Ultra-widefield fundus mosaic · image size 1924x1556
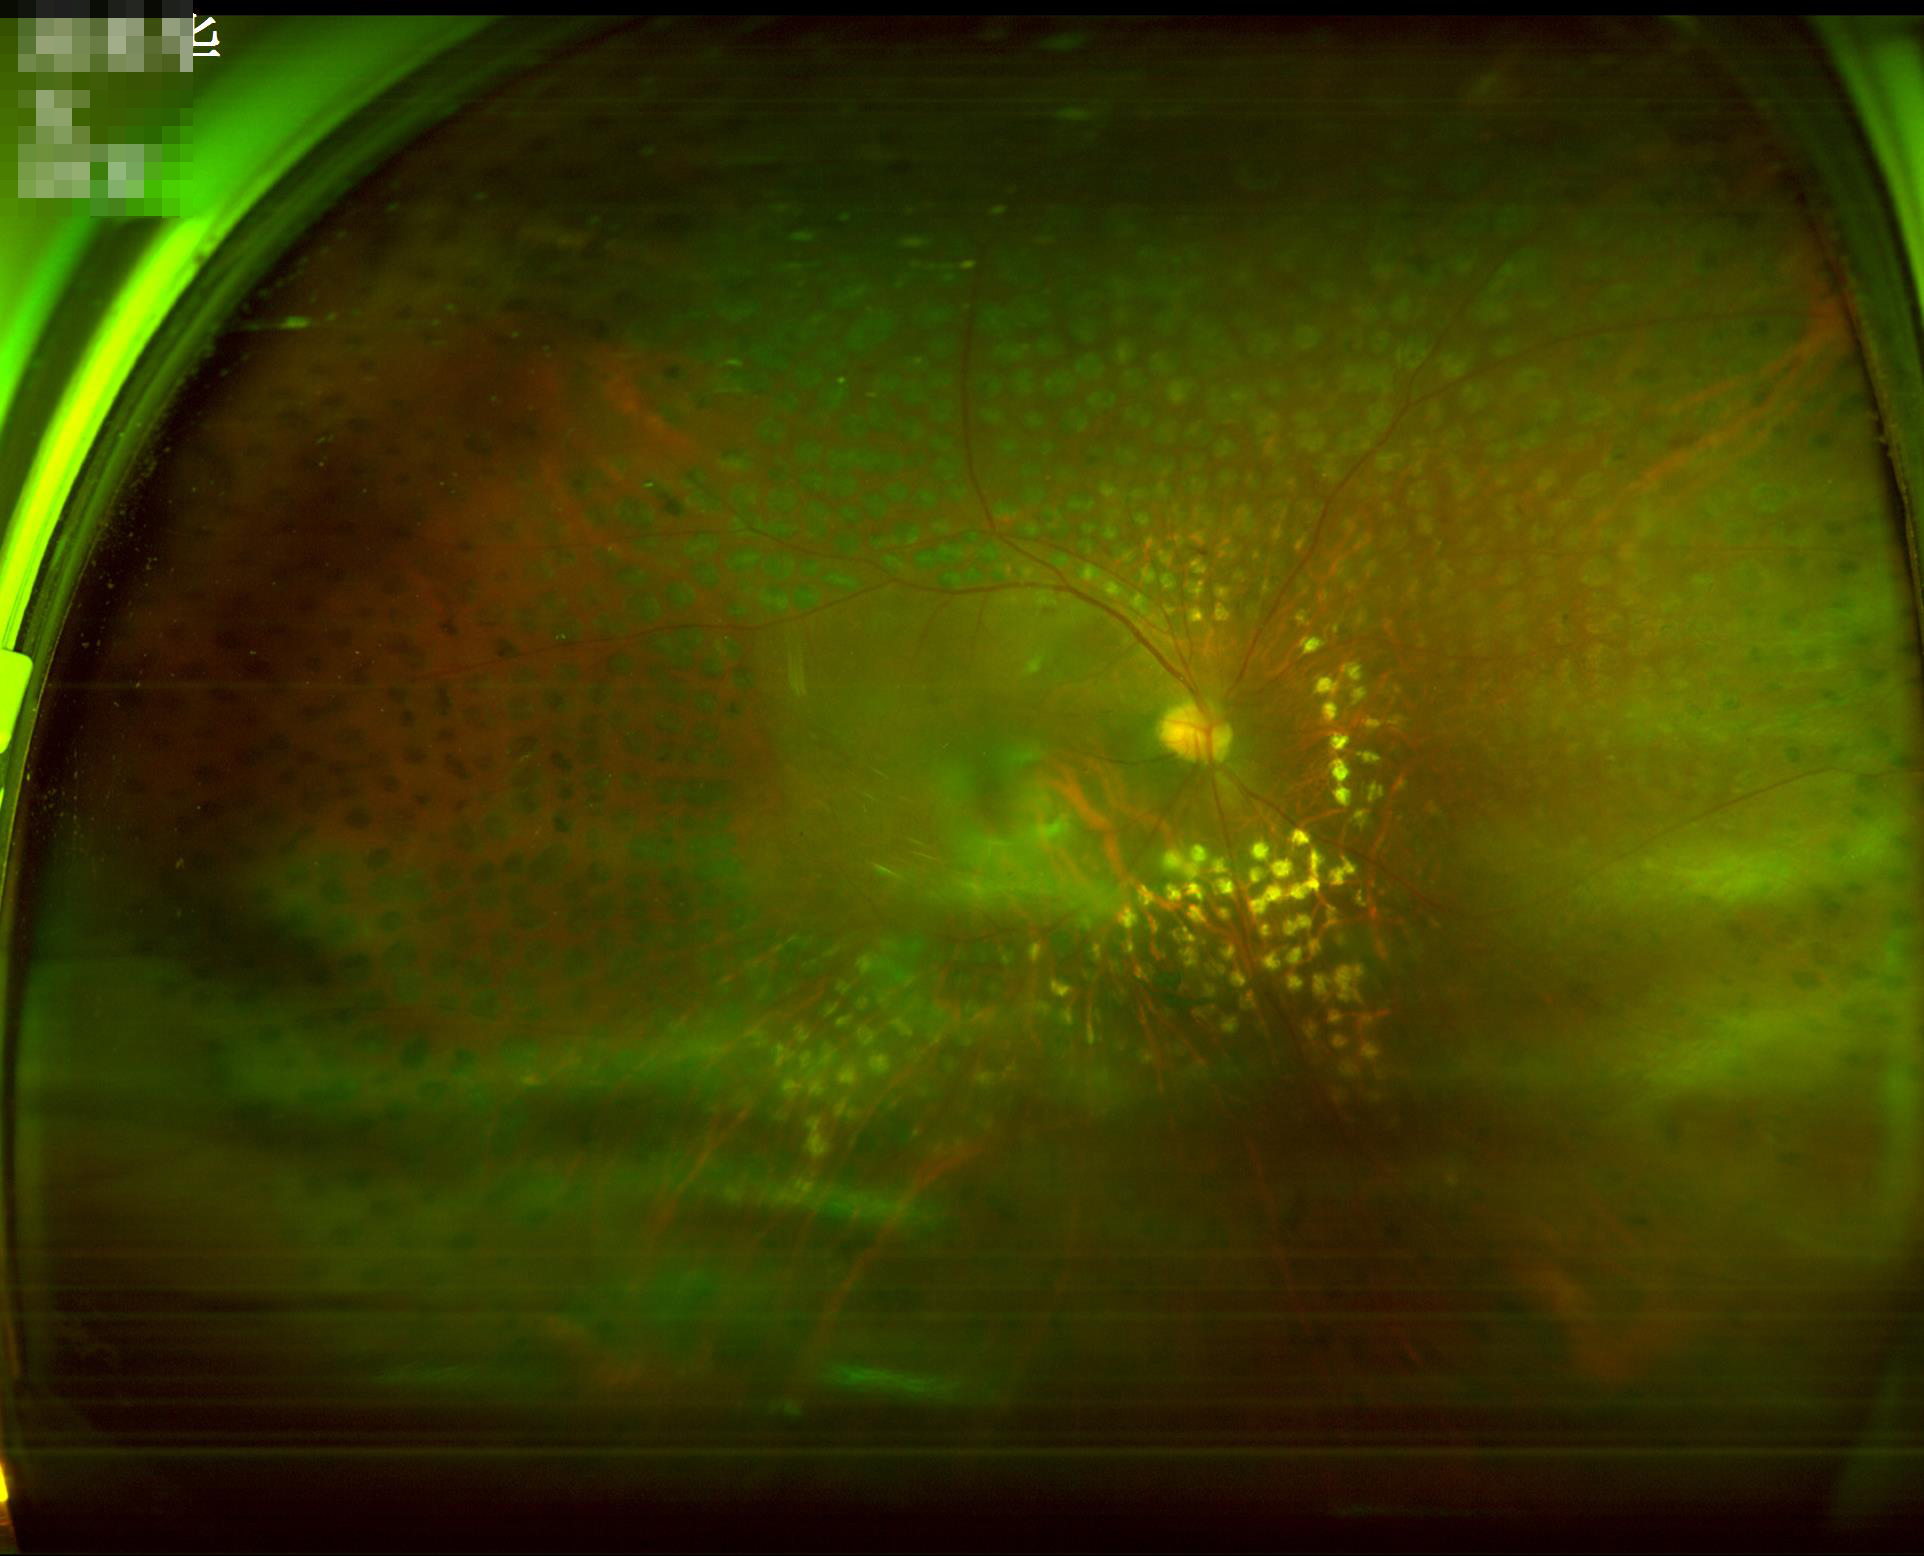

Illumination and color balance are good. Contrast is good. Overall quality is good and the image is gradable. Reduced sharpness with visible blur.